CFP: 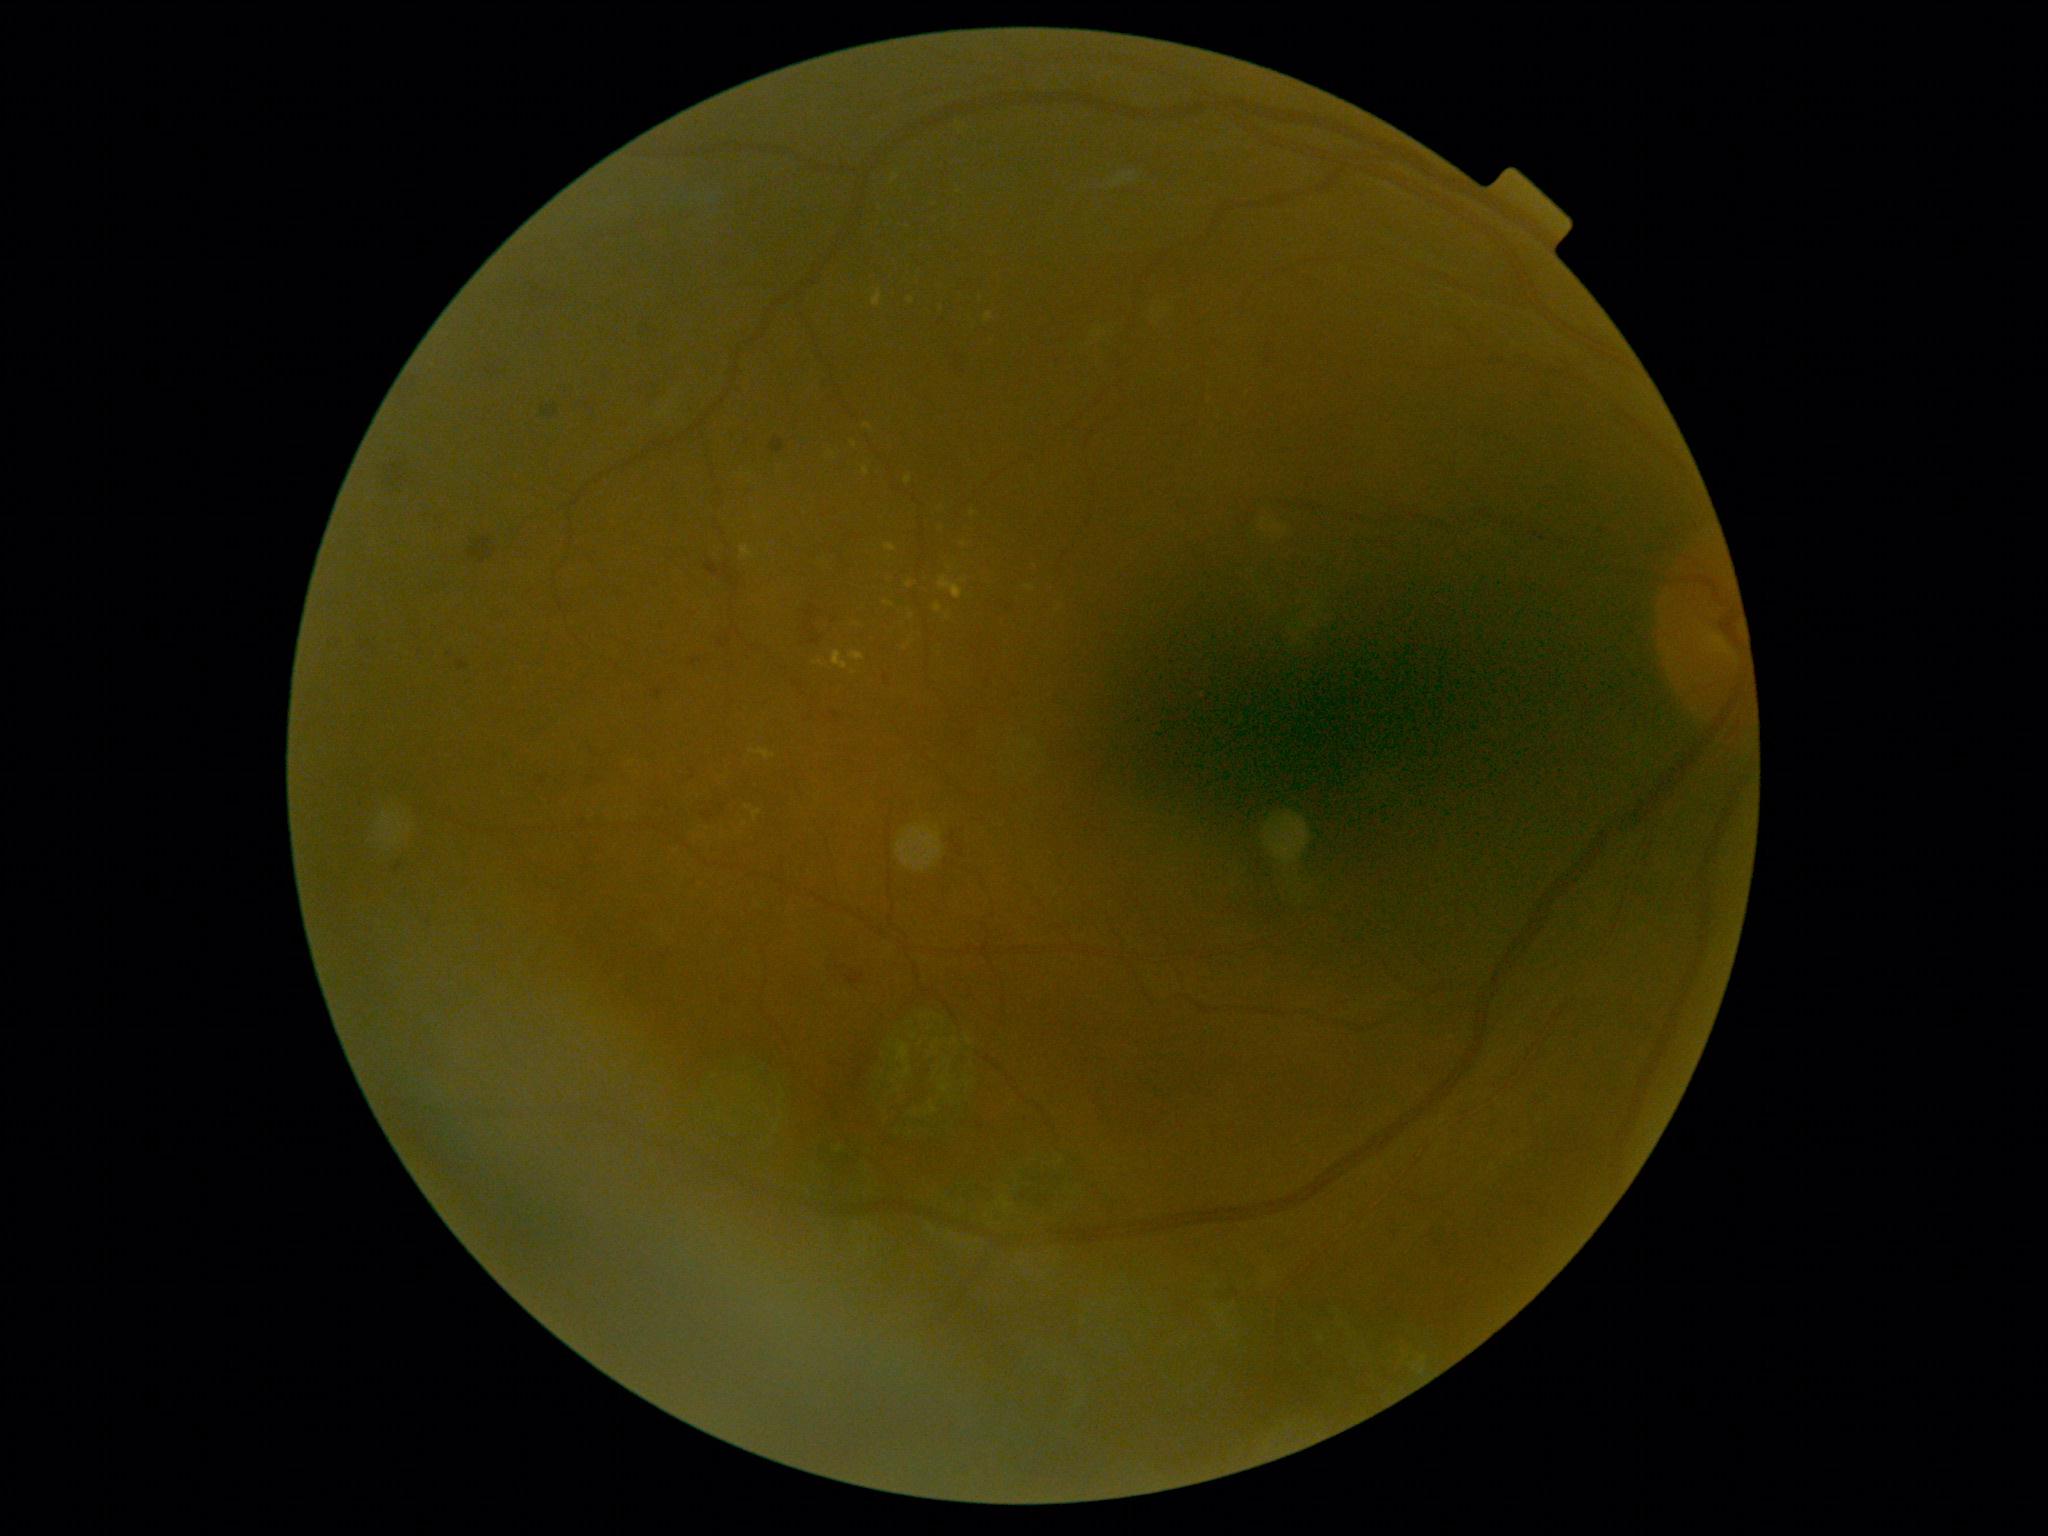

Retinopathy is grade 2 (moderate NPDR).